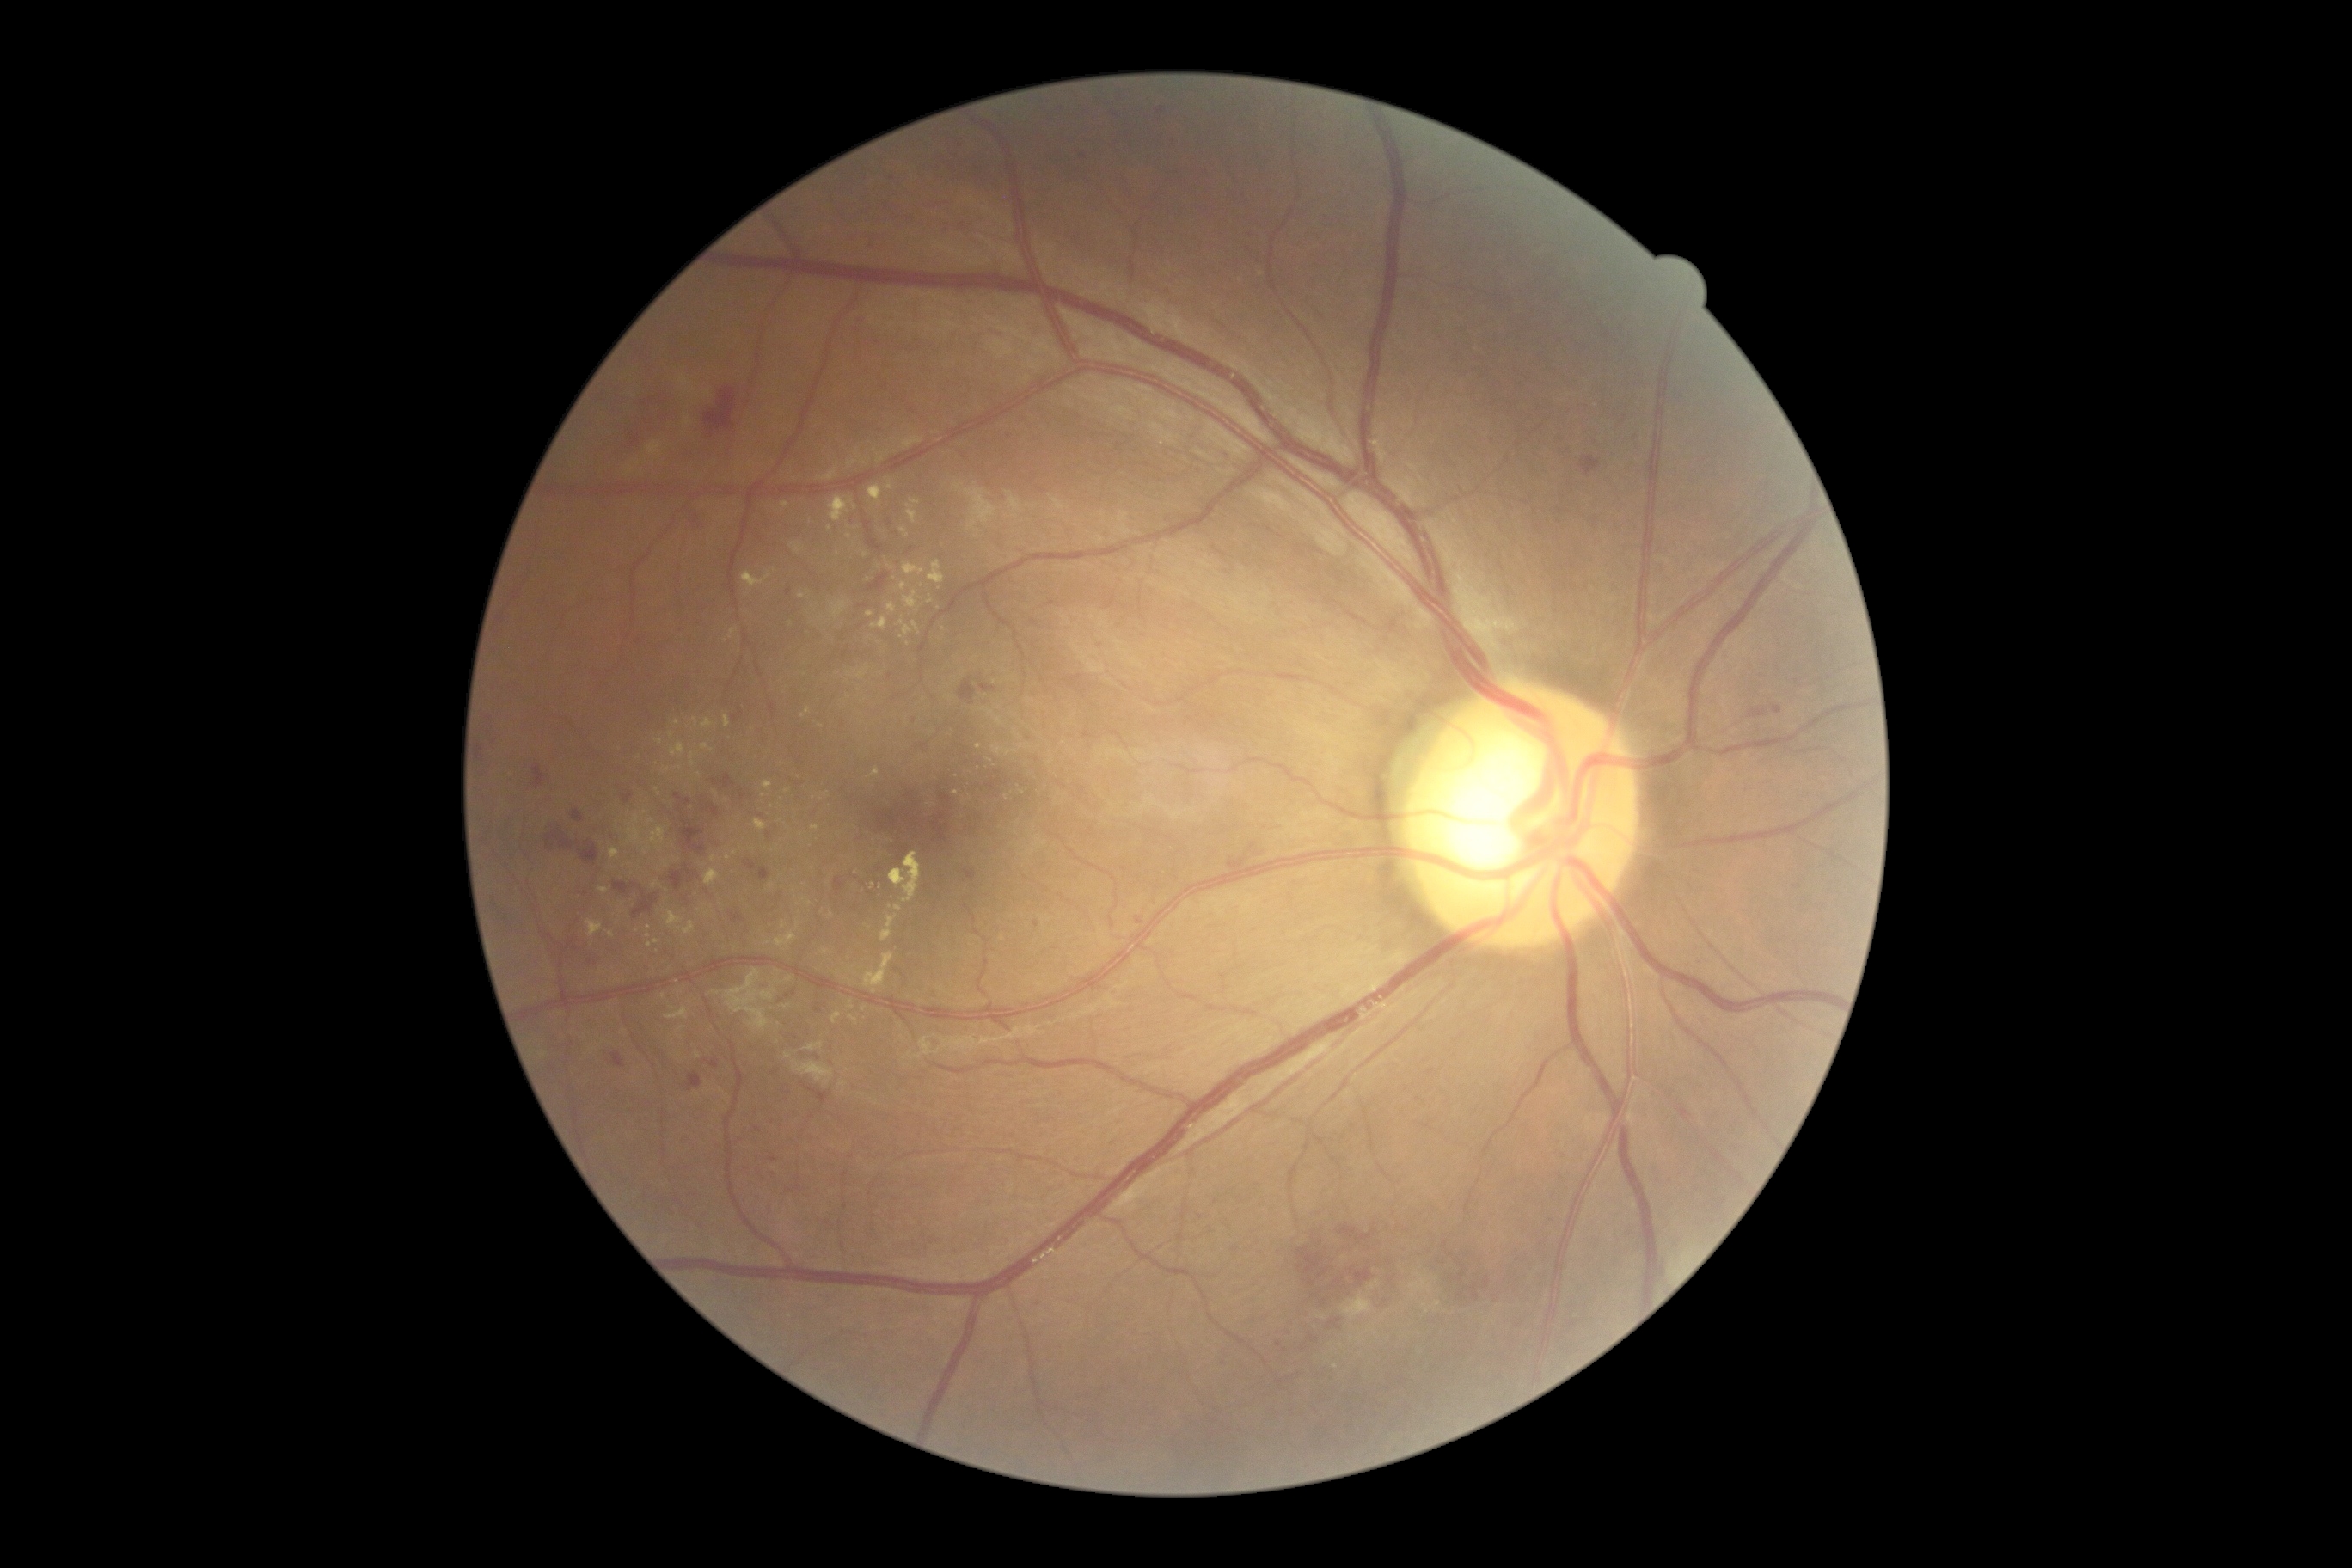 Diabetic retinopathy grade: 2 — more than just microaneurysms but less than severe NPDR
Representative lesions:
• hard exudates (partial): {"left": 895, "top": 907, "right": 903, "bottom": 912}; {"left": 652, "top": 881, "right": 659, "bottom": 890}; {"left": 628, "top": 814, "right": 644, "bottom": 847}; {"left": 888, "top": 852, "right": 922, "bottom": 903}; {"left": 912, "top": 501, "right": 921, "bottom": 505}; {"left": 702, "top": 718, "right": 714, "bottom": 730}; {"left": 903, "top": 592, "right": 917, "bottom": 609}; {"left": 903, "top": 563, "right": 924, "bottom": 577}; {"left": 763, "top": 781, "right": 773, "bottom": 790}; {"left": 900, "top": 527, "right": 910, "bottom": 537}
• Small hard exudates approximately at 849:536; 677:723; 681:1029; 874:887; 864:1010; 673:1008; 830:528; 735:853
• soft exudates: none identified
• hemorrhages (partial): {"left": 986, "top": 778, "right": 1001, "bottom": 792}; {"left": 757, "top": 869, "right": 771, "bottom": 881}; {"left": 802, "top": 1082, "right": 830, "bottom": 1106}; {"left": 1314, "top": 1240, "right": 1323, "bottom": 1247}; {"left": 704, "top": 386, "right": 738, "bottom": 439}; {"left": 678, "top": 805, "right": 706, "bottom": 855}; {"left": 1299, "top": 1247, "right": 1402, "bottom": 1316}; {"left": 687, "top": 1072, "right": 704, "bottom": 1091}; {"left": 634, "top": 888, "right": 659, "bottom": 921}; {"left": 1581, "top": 456, "right": 1602, "bottom": 477}; {"left": 541, "top": 929, "right": 553, "bottom": 938}; {"left": 1330, "top": 1320, "right": 1342, "bottom": 1330}; {"left": 675, "top": 793, "right": 690, "bottom": 805}; {"left": 615, "top": 883, "right": 637, "bottom": 895}
• Small hemorrhages approximately at 1450:1280; 1447:1245; 1280:1345
• microaneurysms: {"left": 1772, "top": 706, "right": 1782, "bottom": 716}; {"left": 1136, "top": 917, "right": 1146, "bottom": 924}; {"left": 706, "top": 1058, "right": 720, "bottom": 1070}; {"left": 611, "top": 1053, "right": 625, "bottom": 1069}
• Small microaneurysms approximately at 1285:1350; 774:1160; 1161:110